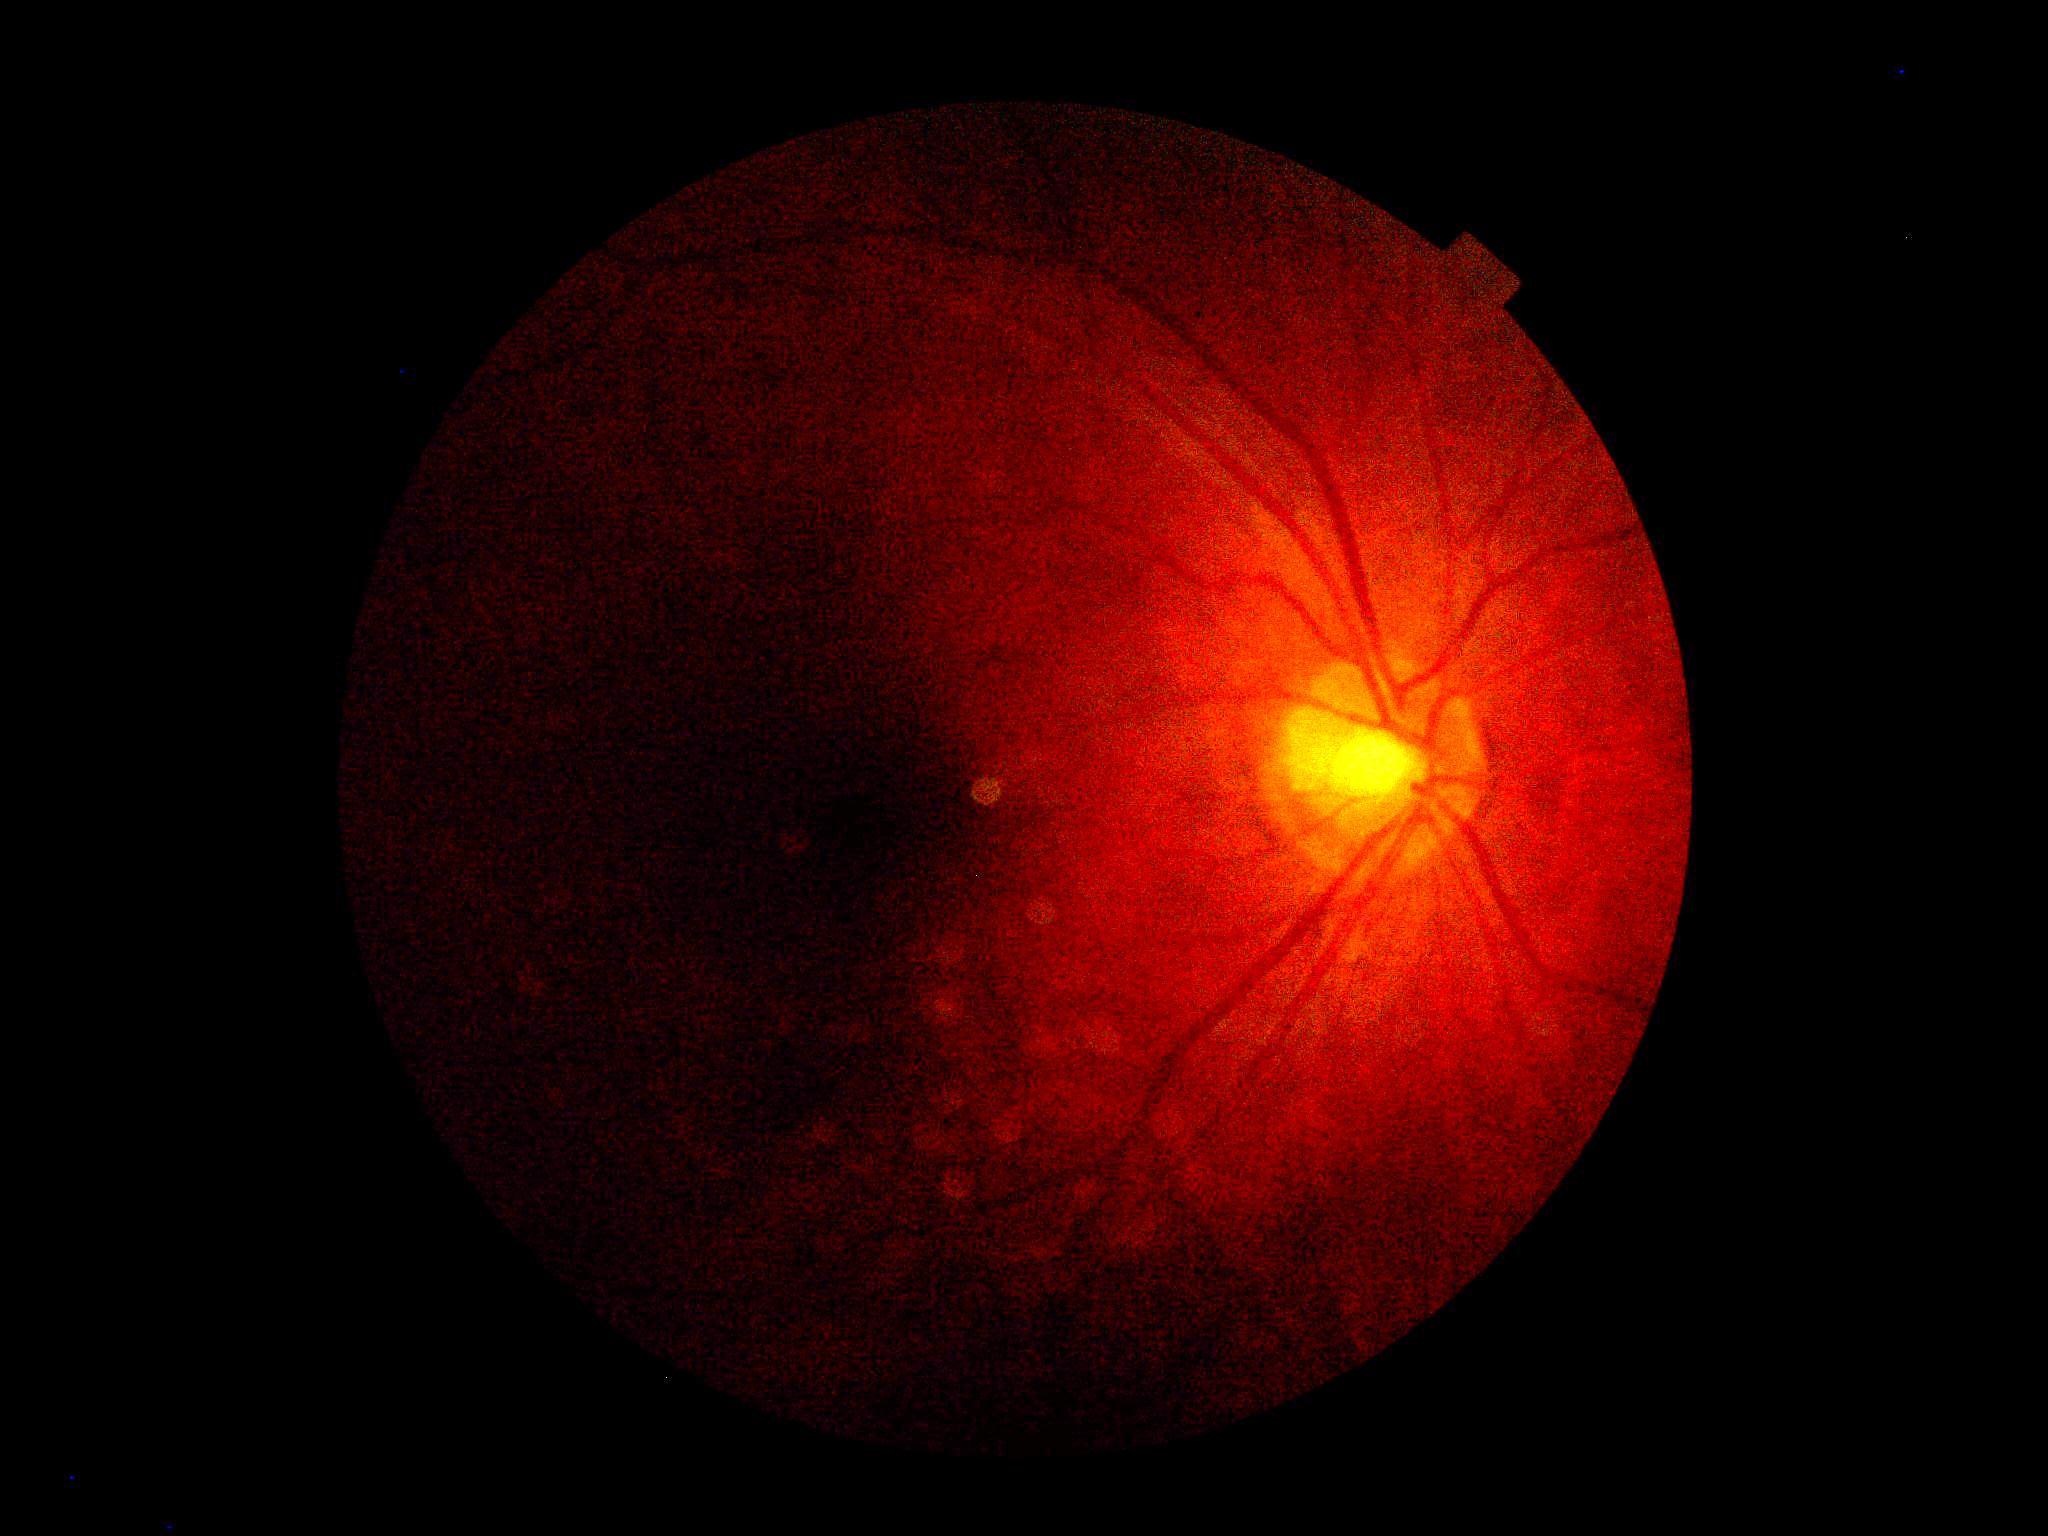 Retinopathy: ungradable.